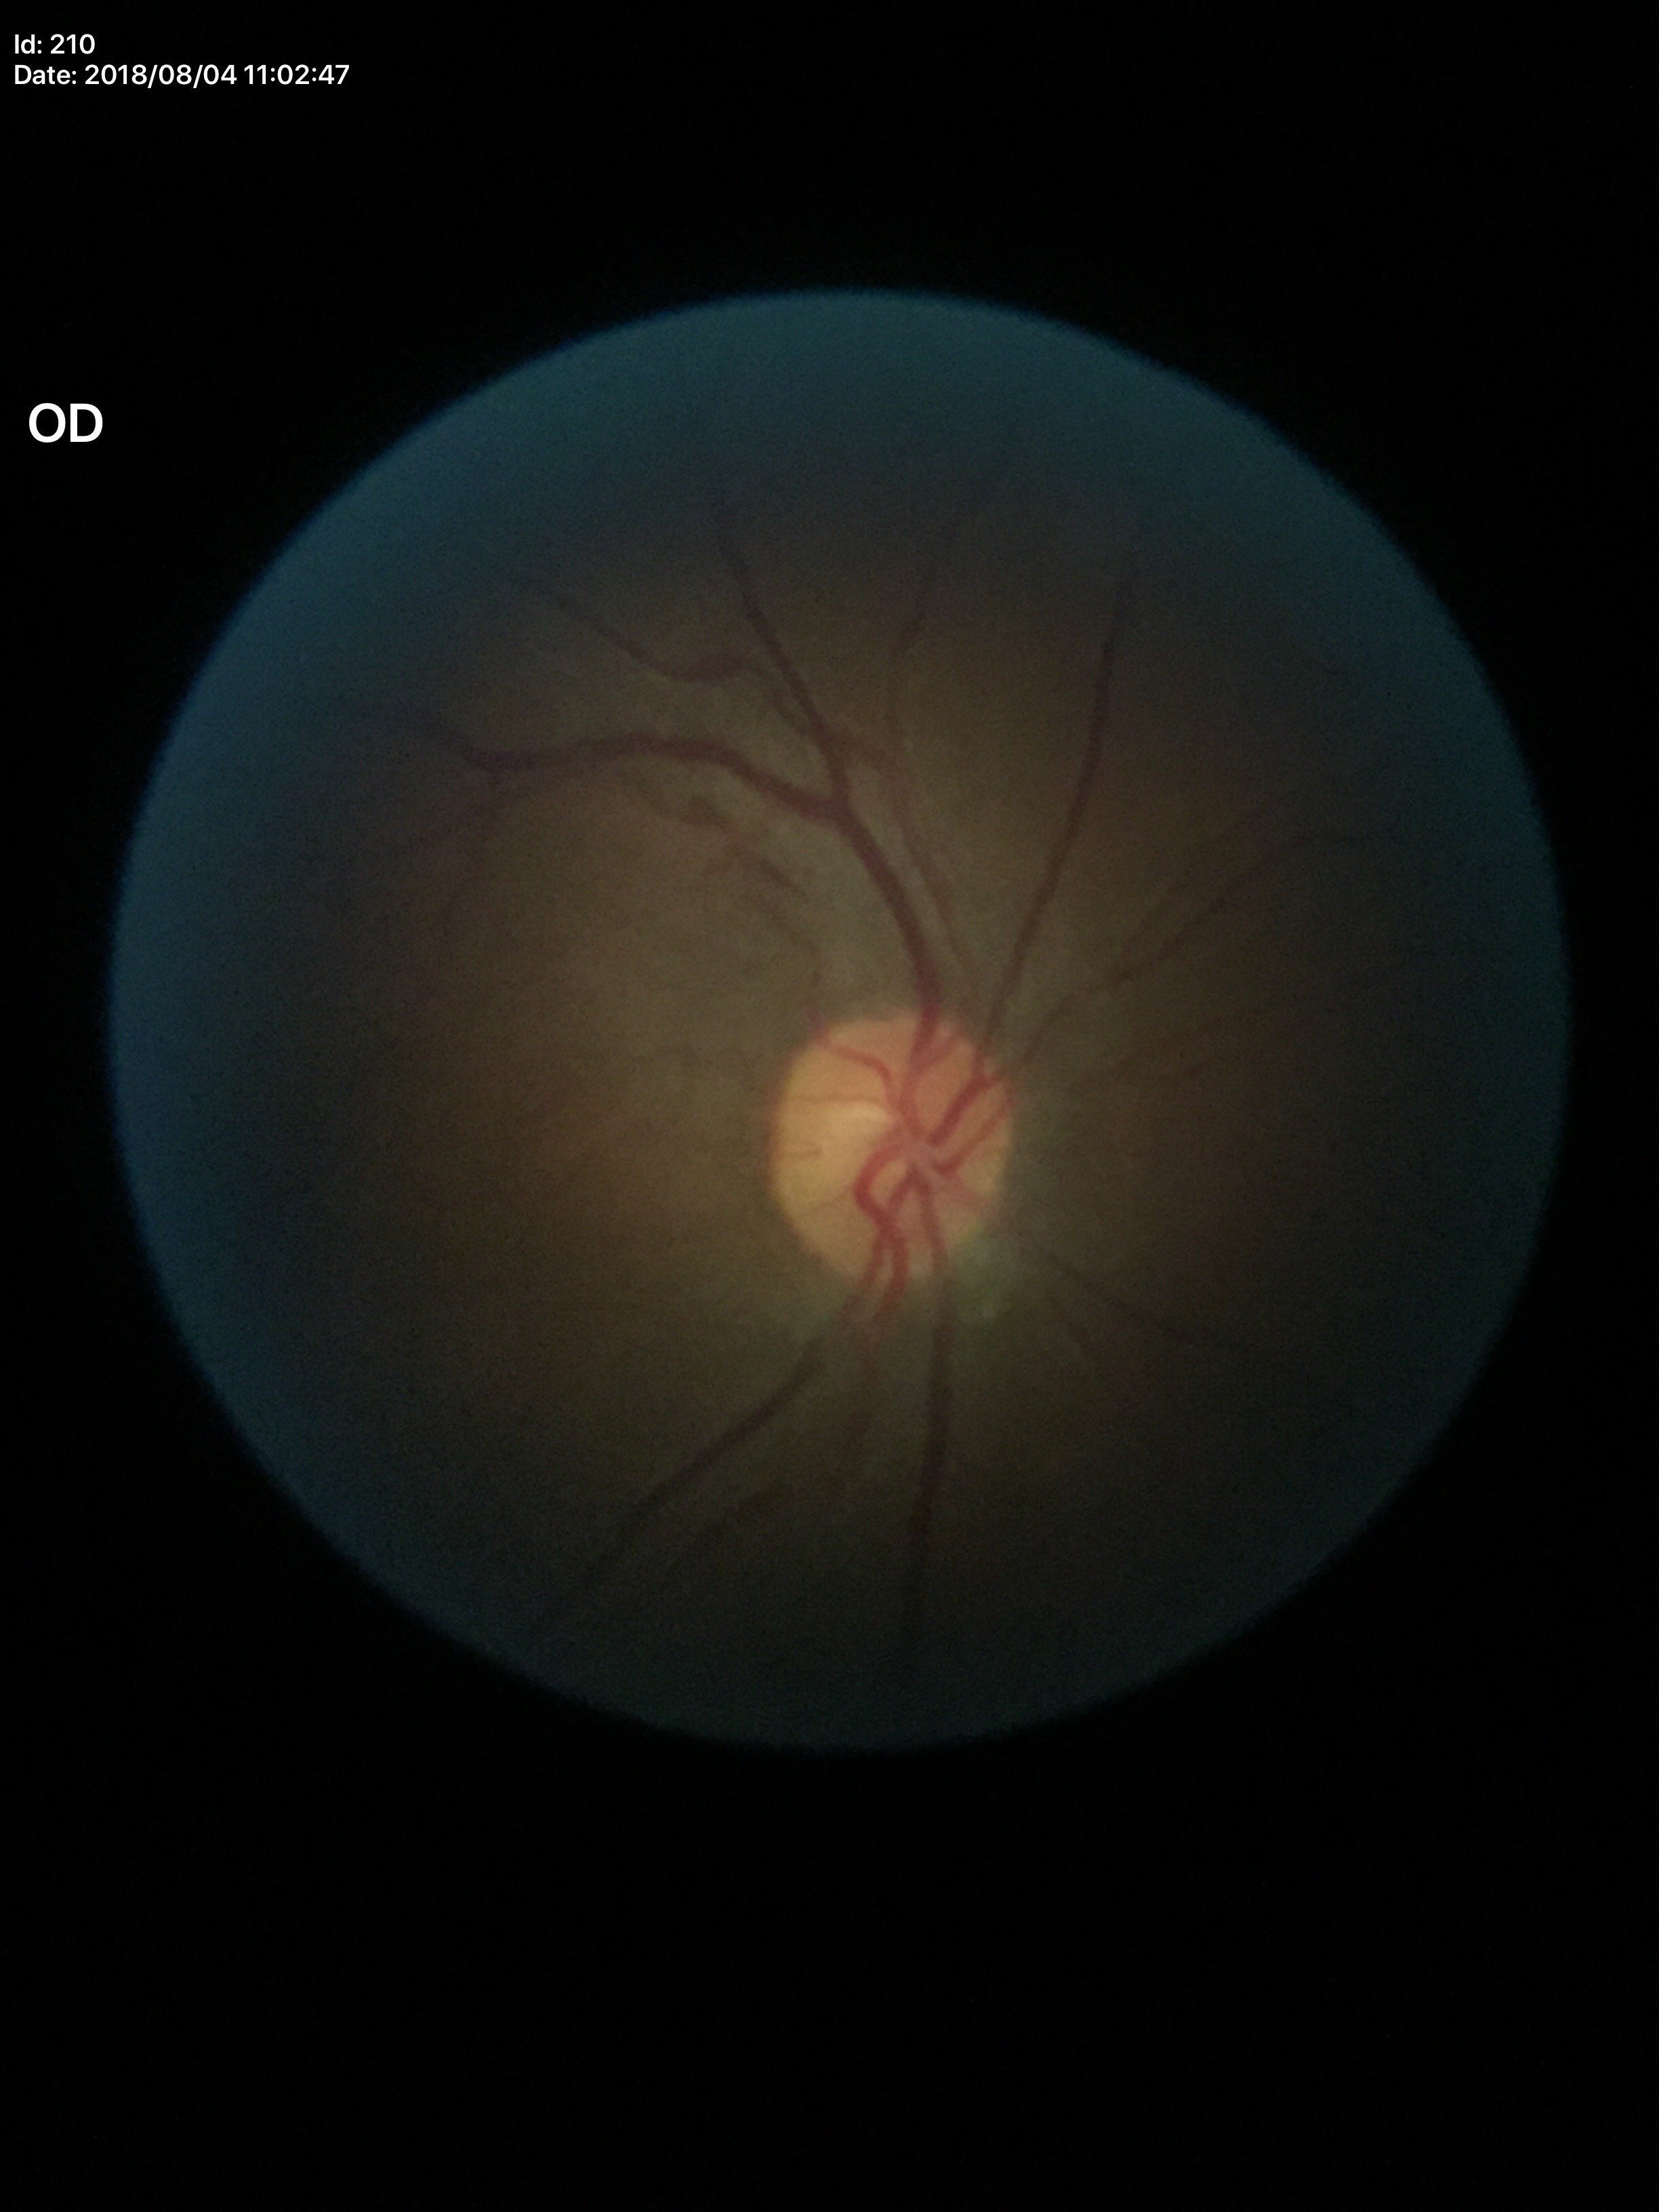
Vertical cup-disc ratio (VCDR) of 0.50.
No glaucomatous findings.